Diabetic retinopathy graded by the modified Davis classification · camera: NIDEK AFC-230: 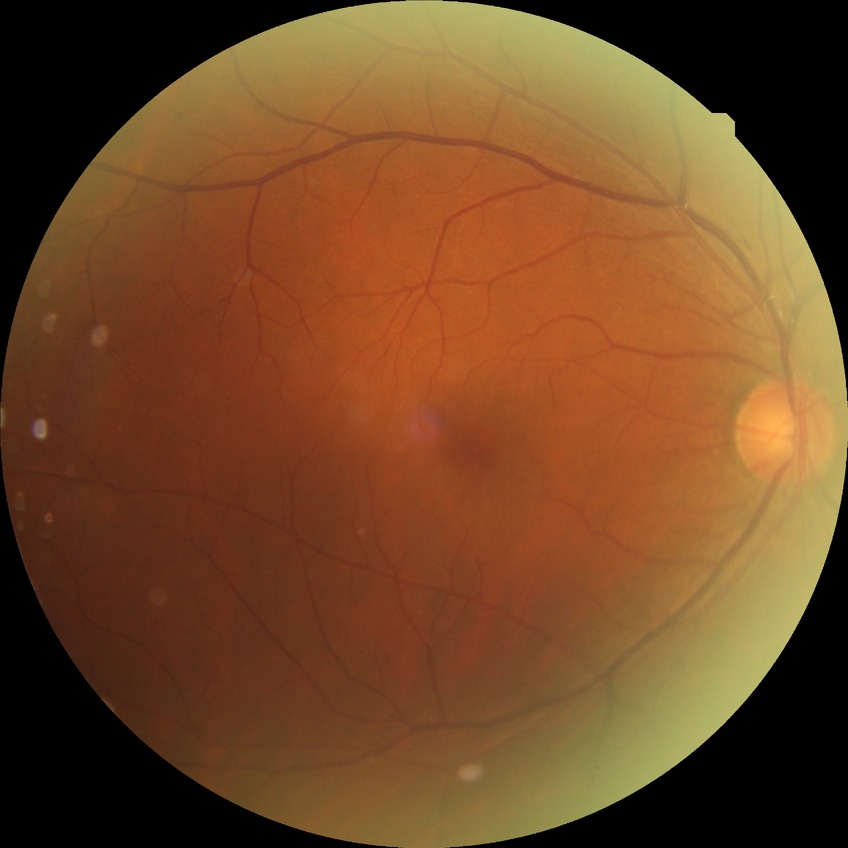
  davis_grade: simple diabetic retinopathy